Disc-centered field, 240x240.
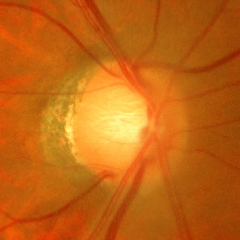 Glaucoma is present. Glaucoma status = early-stage glaucoma.